Wide-field fundus photograph from neonatal ROP screening. 640 x 480 pixels.
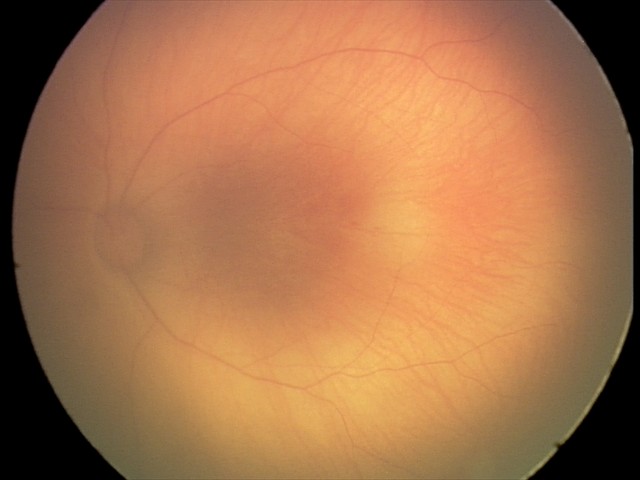 Screening series with retinal hemorrhages.